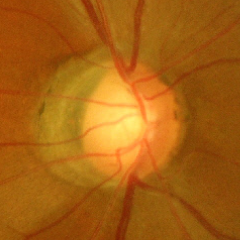

Advanced-stage glaucoma.